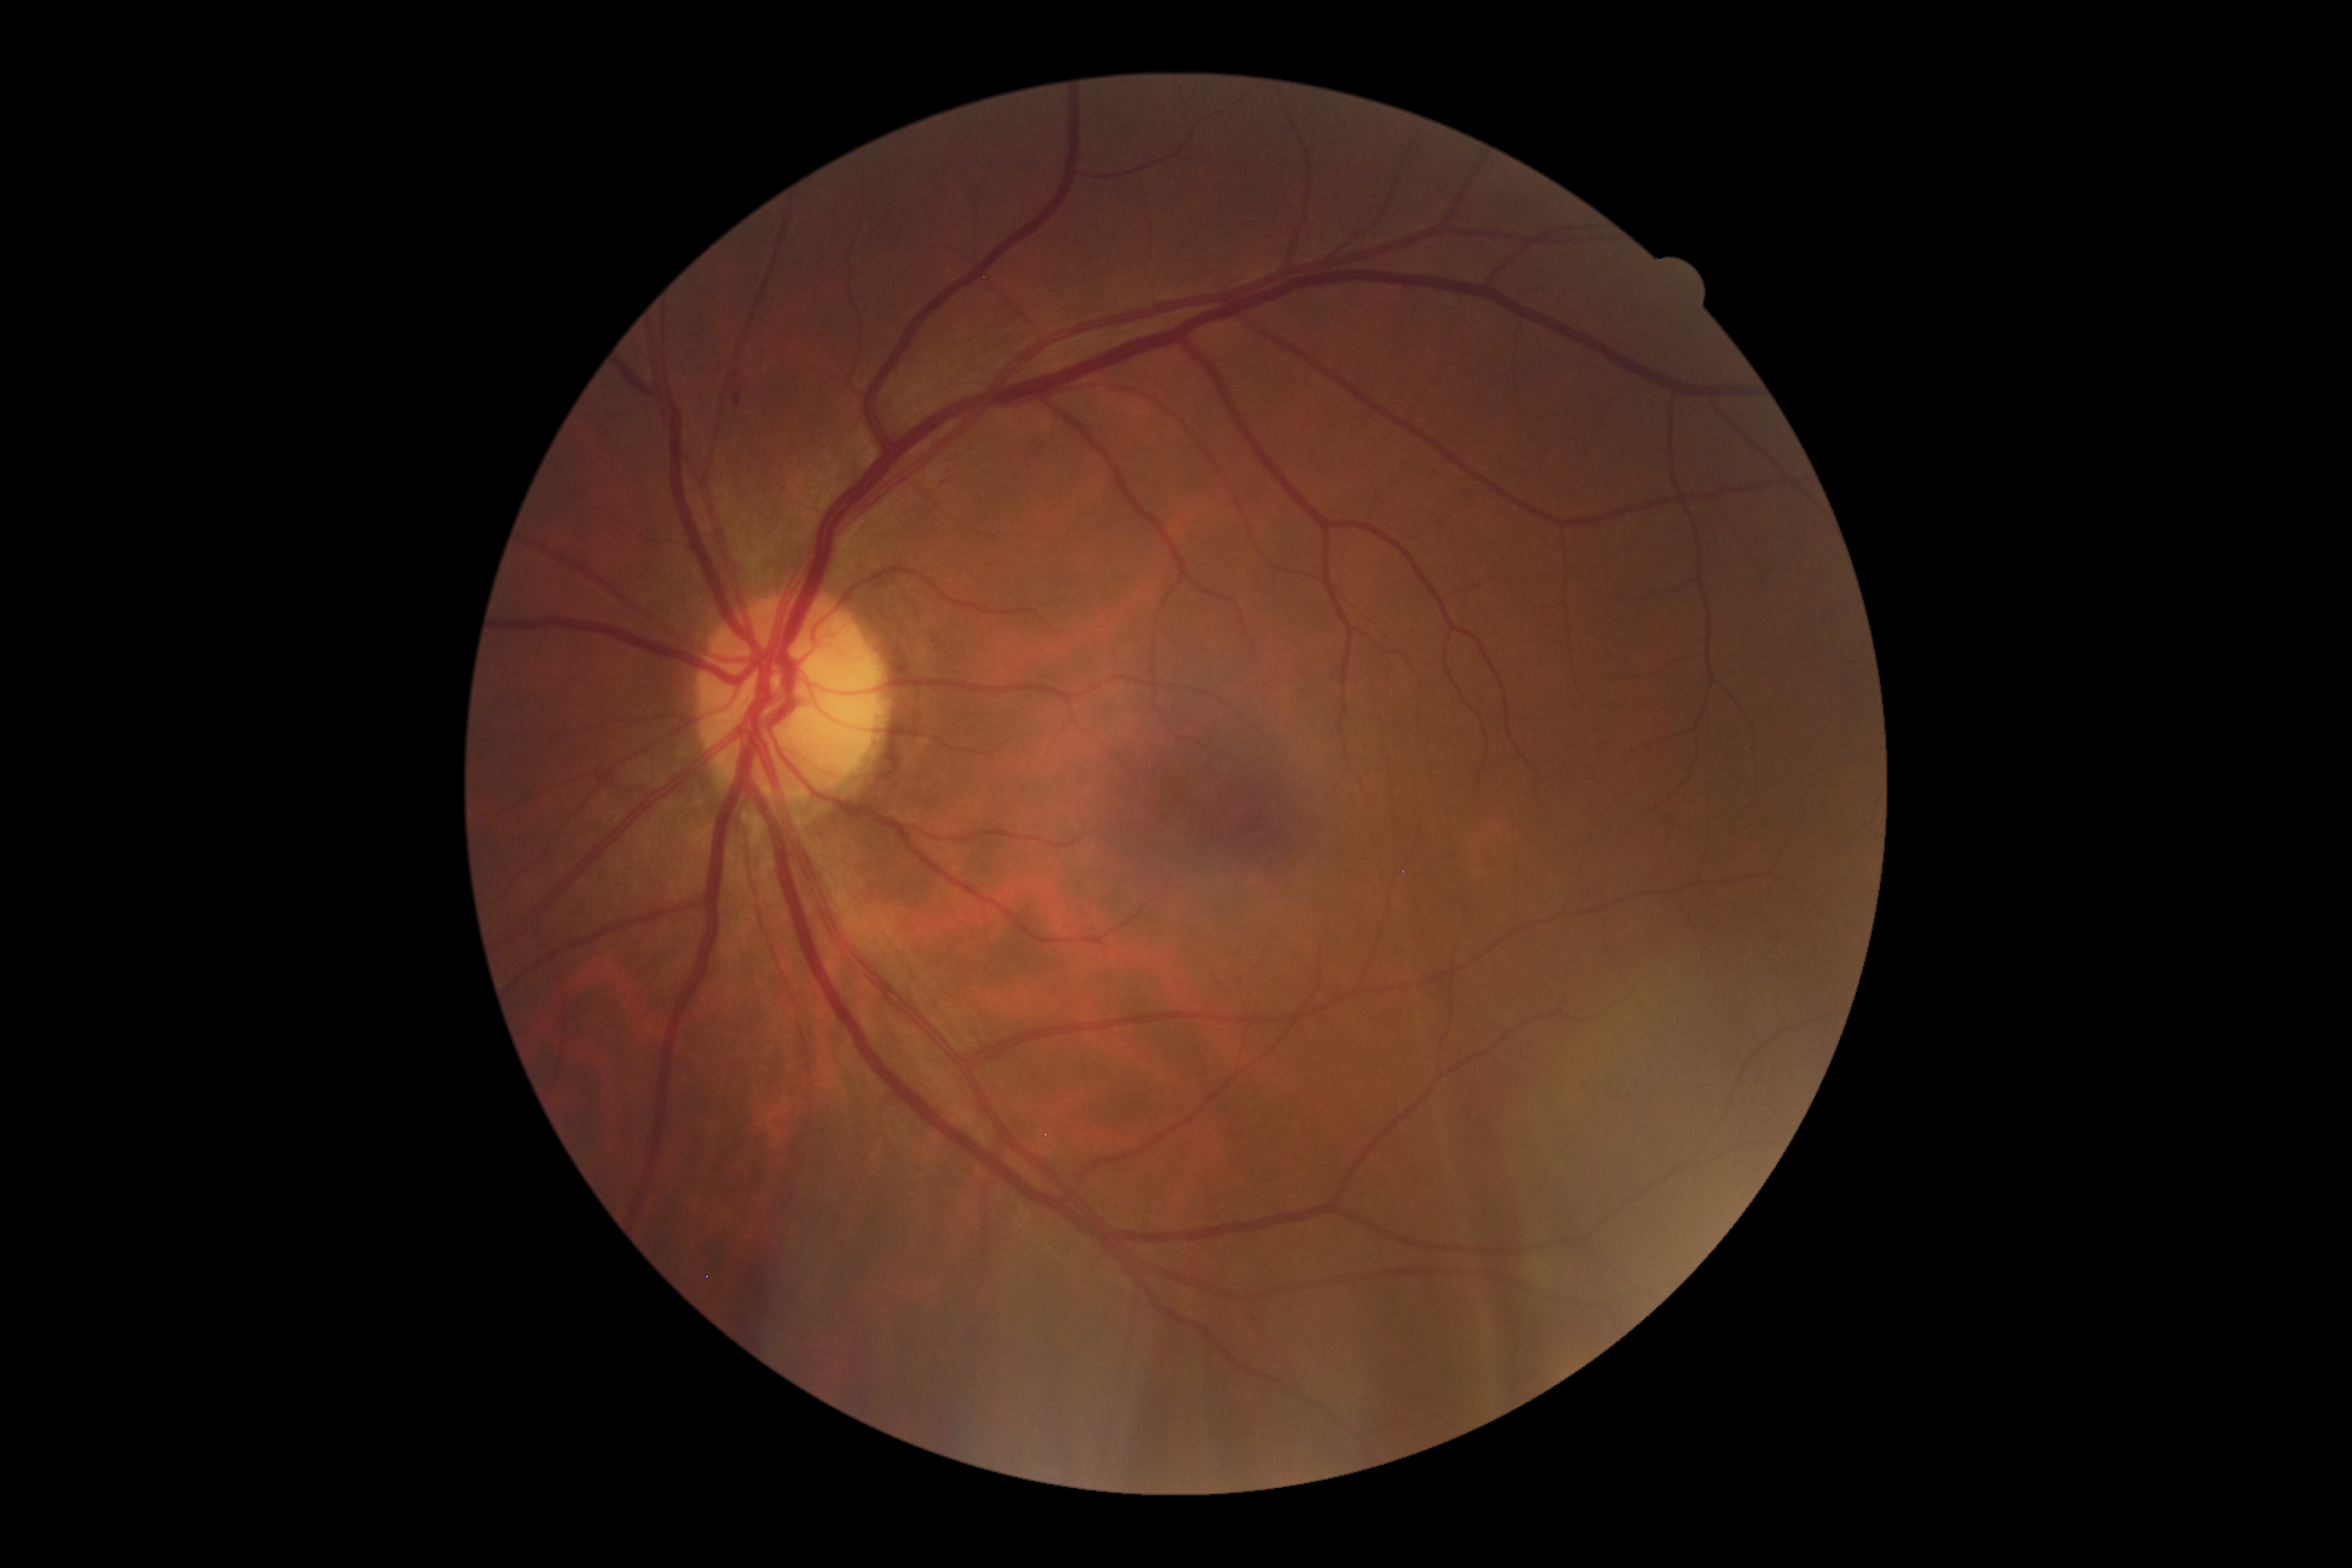
DR class: non-proliferative diabetic retinopathy. DR stage: moderate NPDR (grade 2) — more than just microaneurysms but less than severe NPDR.